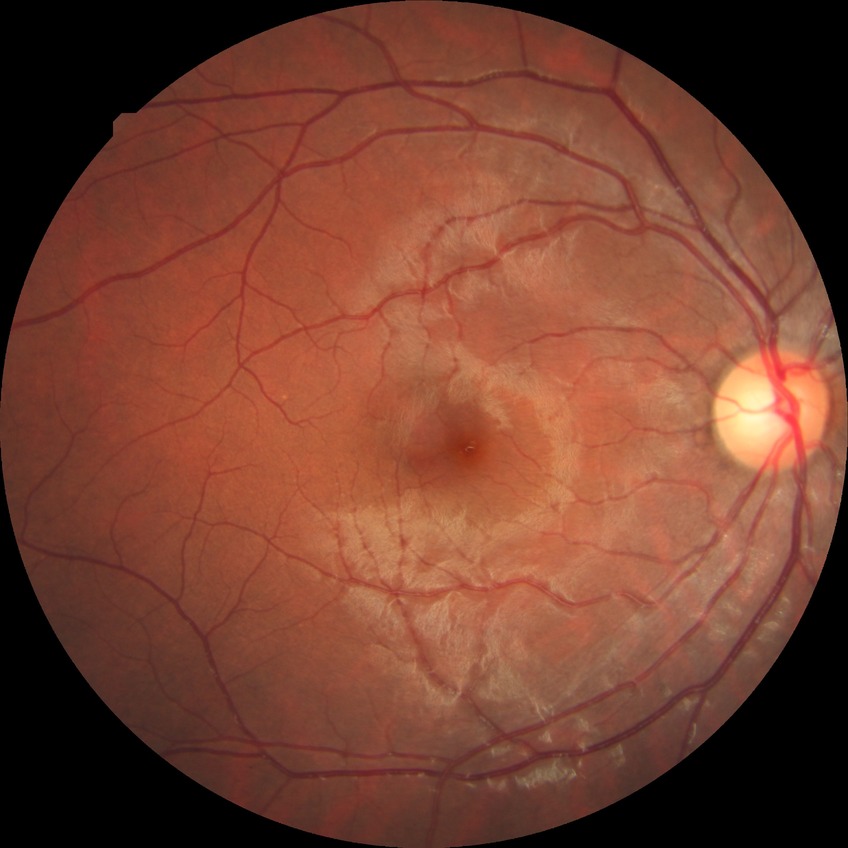

No signs of diabetic retinopathy. DR: NDR.